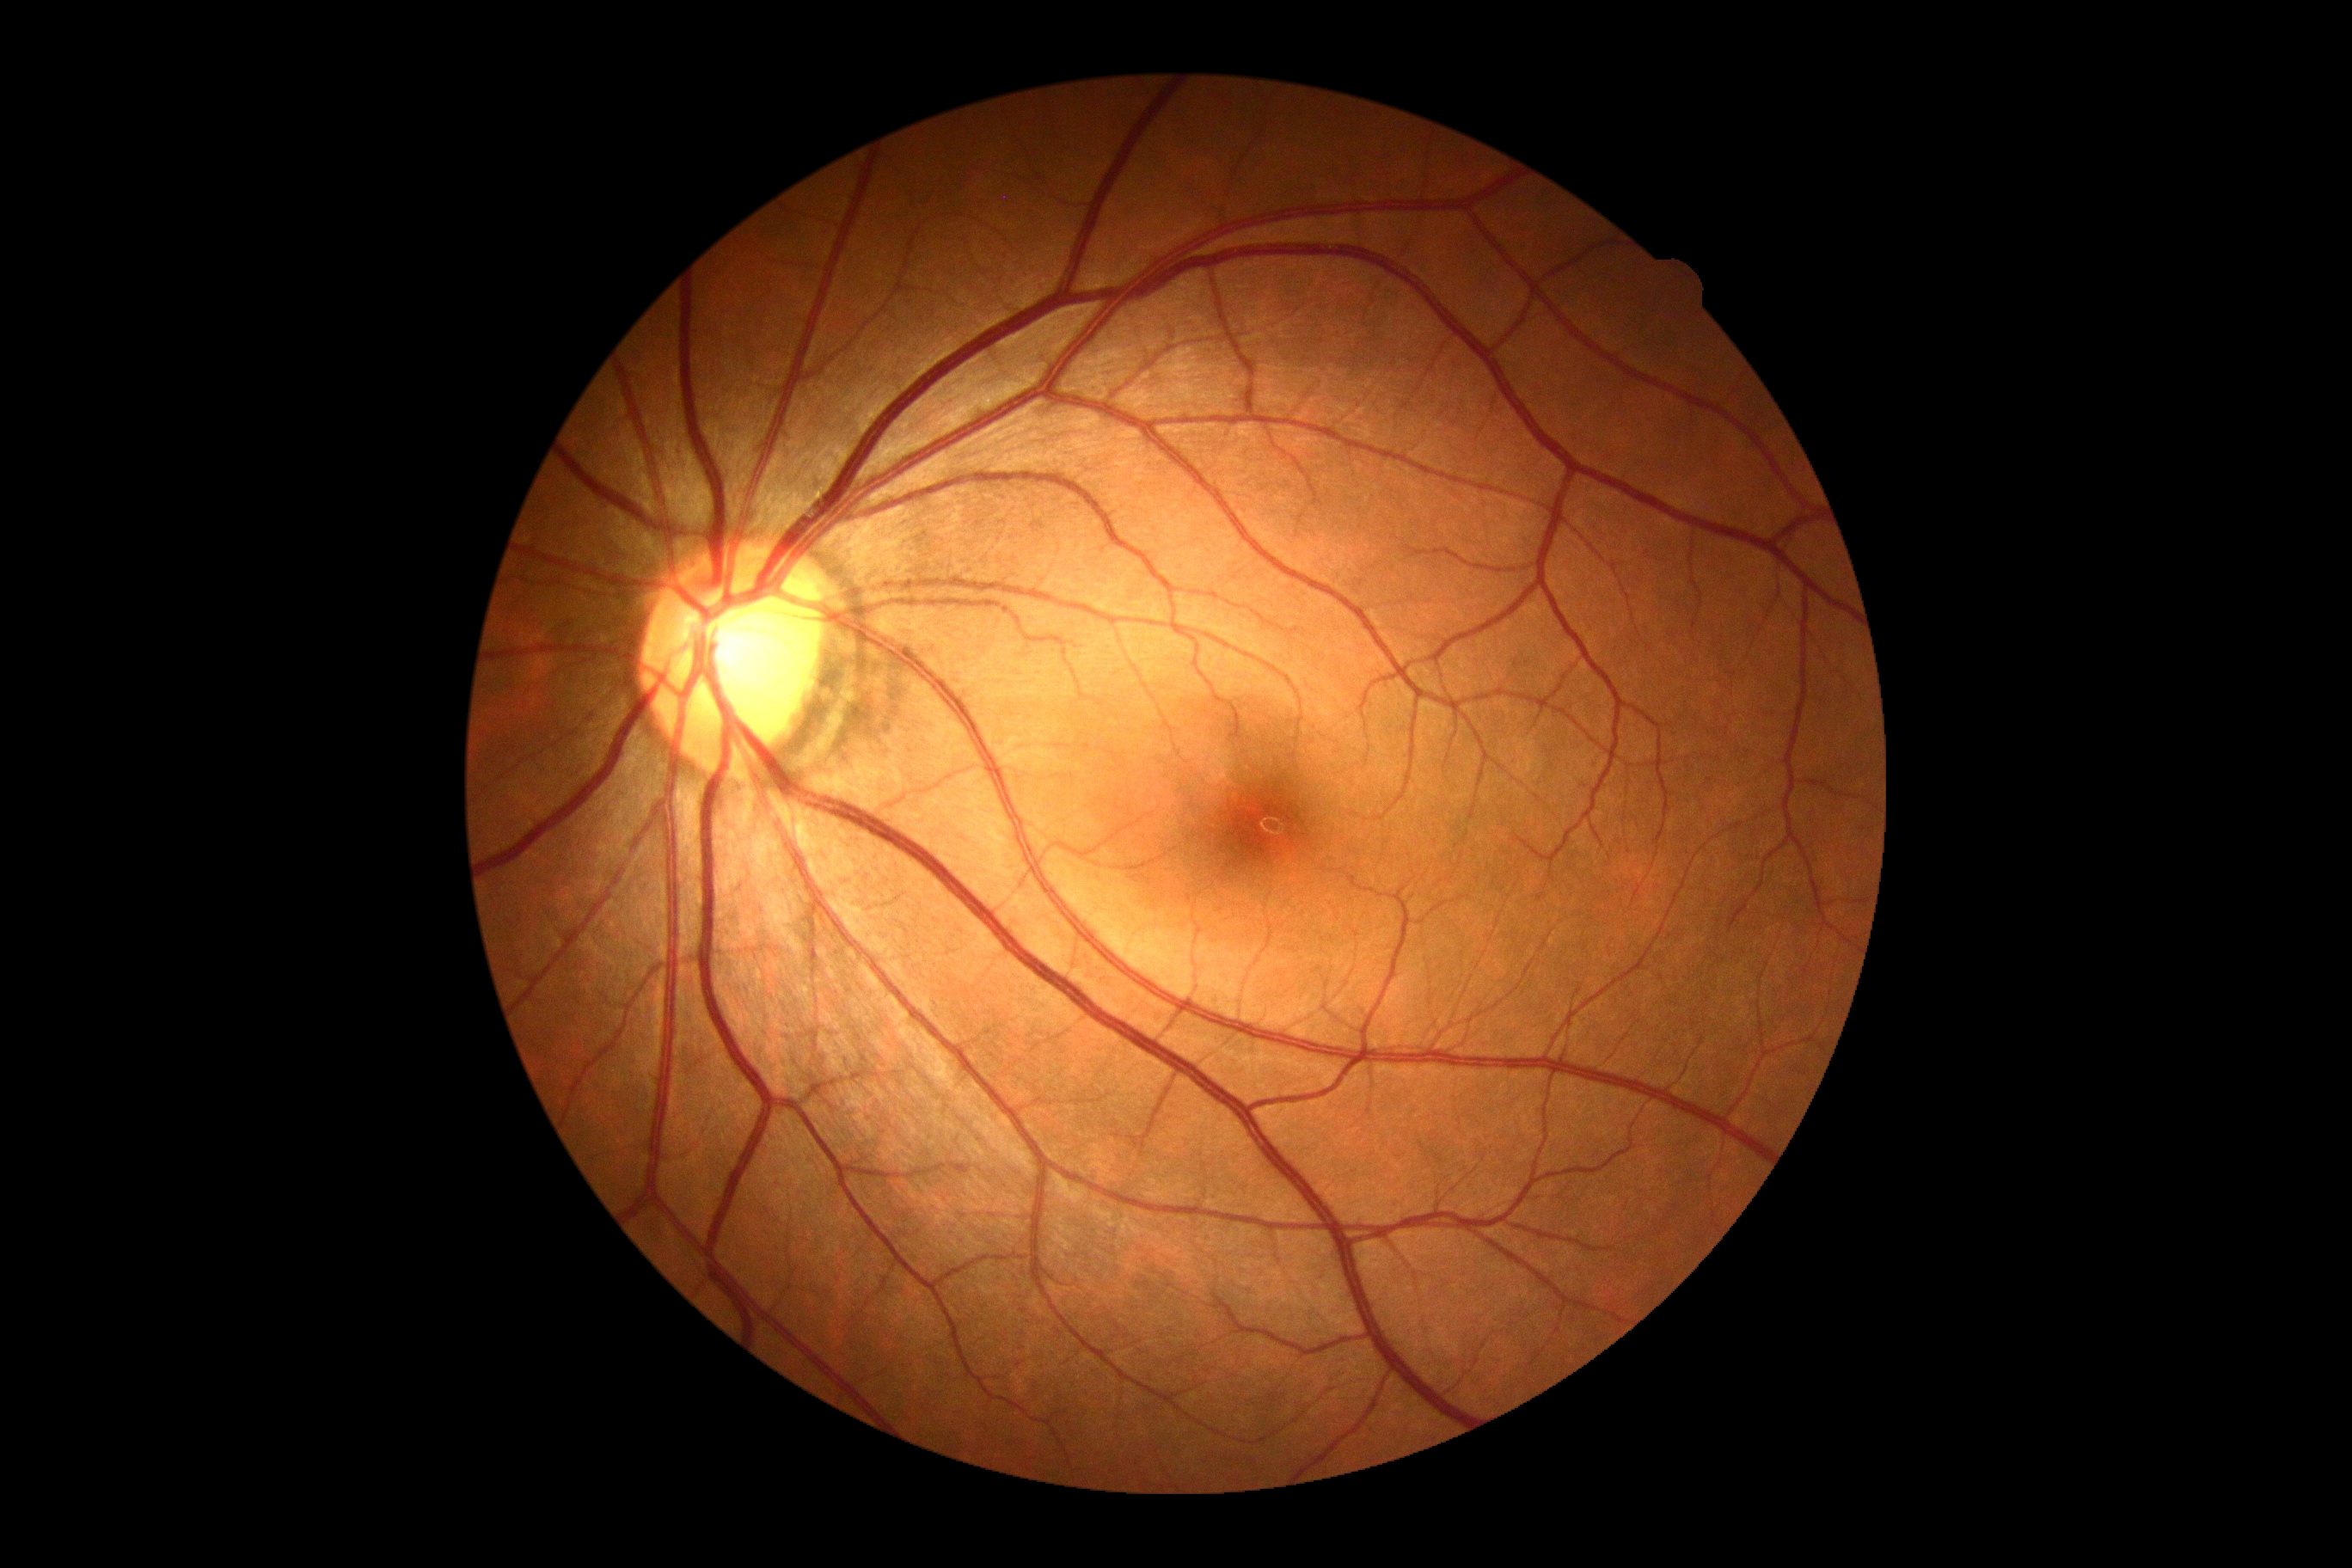 Annotations:
* DR impression: negative for DR
* retinopathy: 0/4